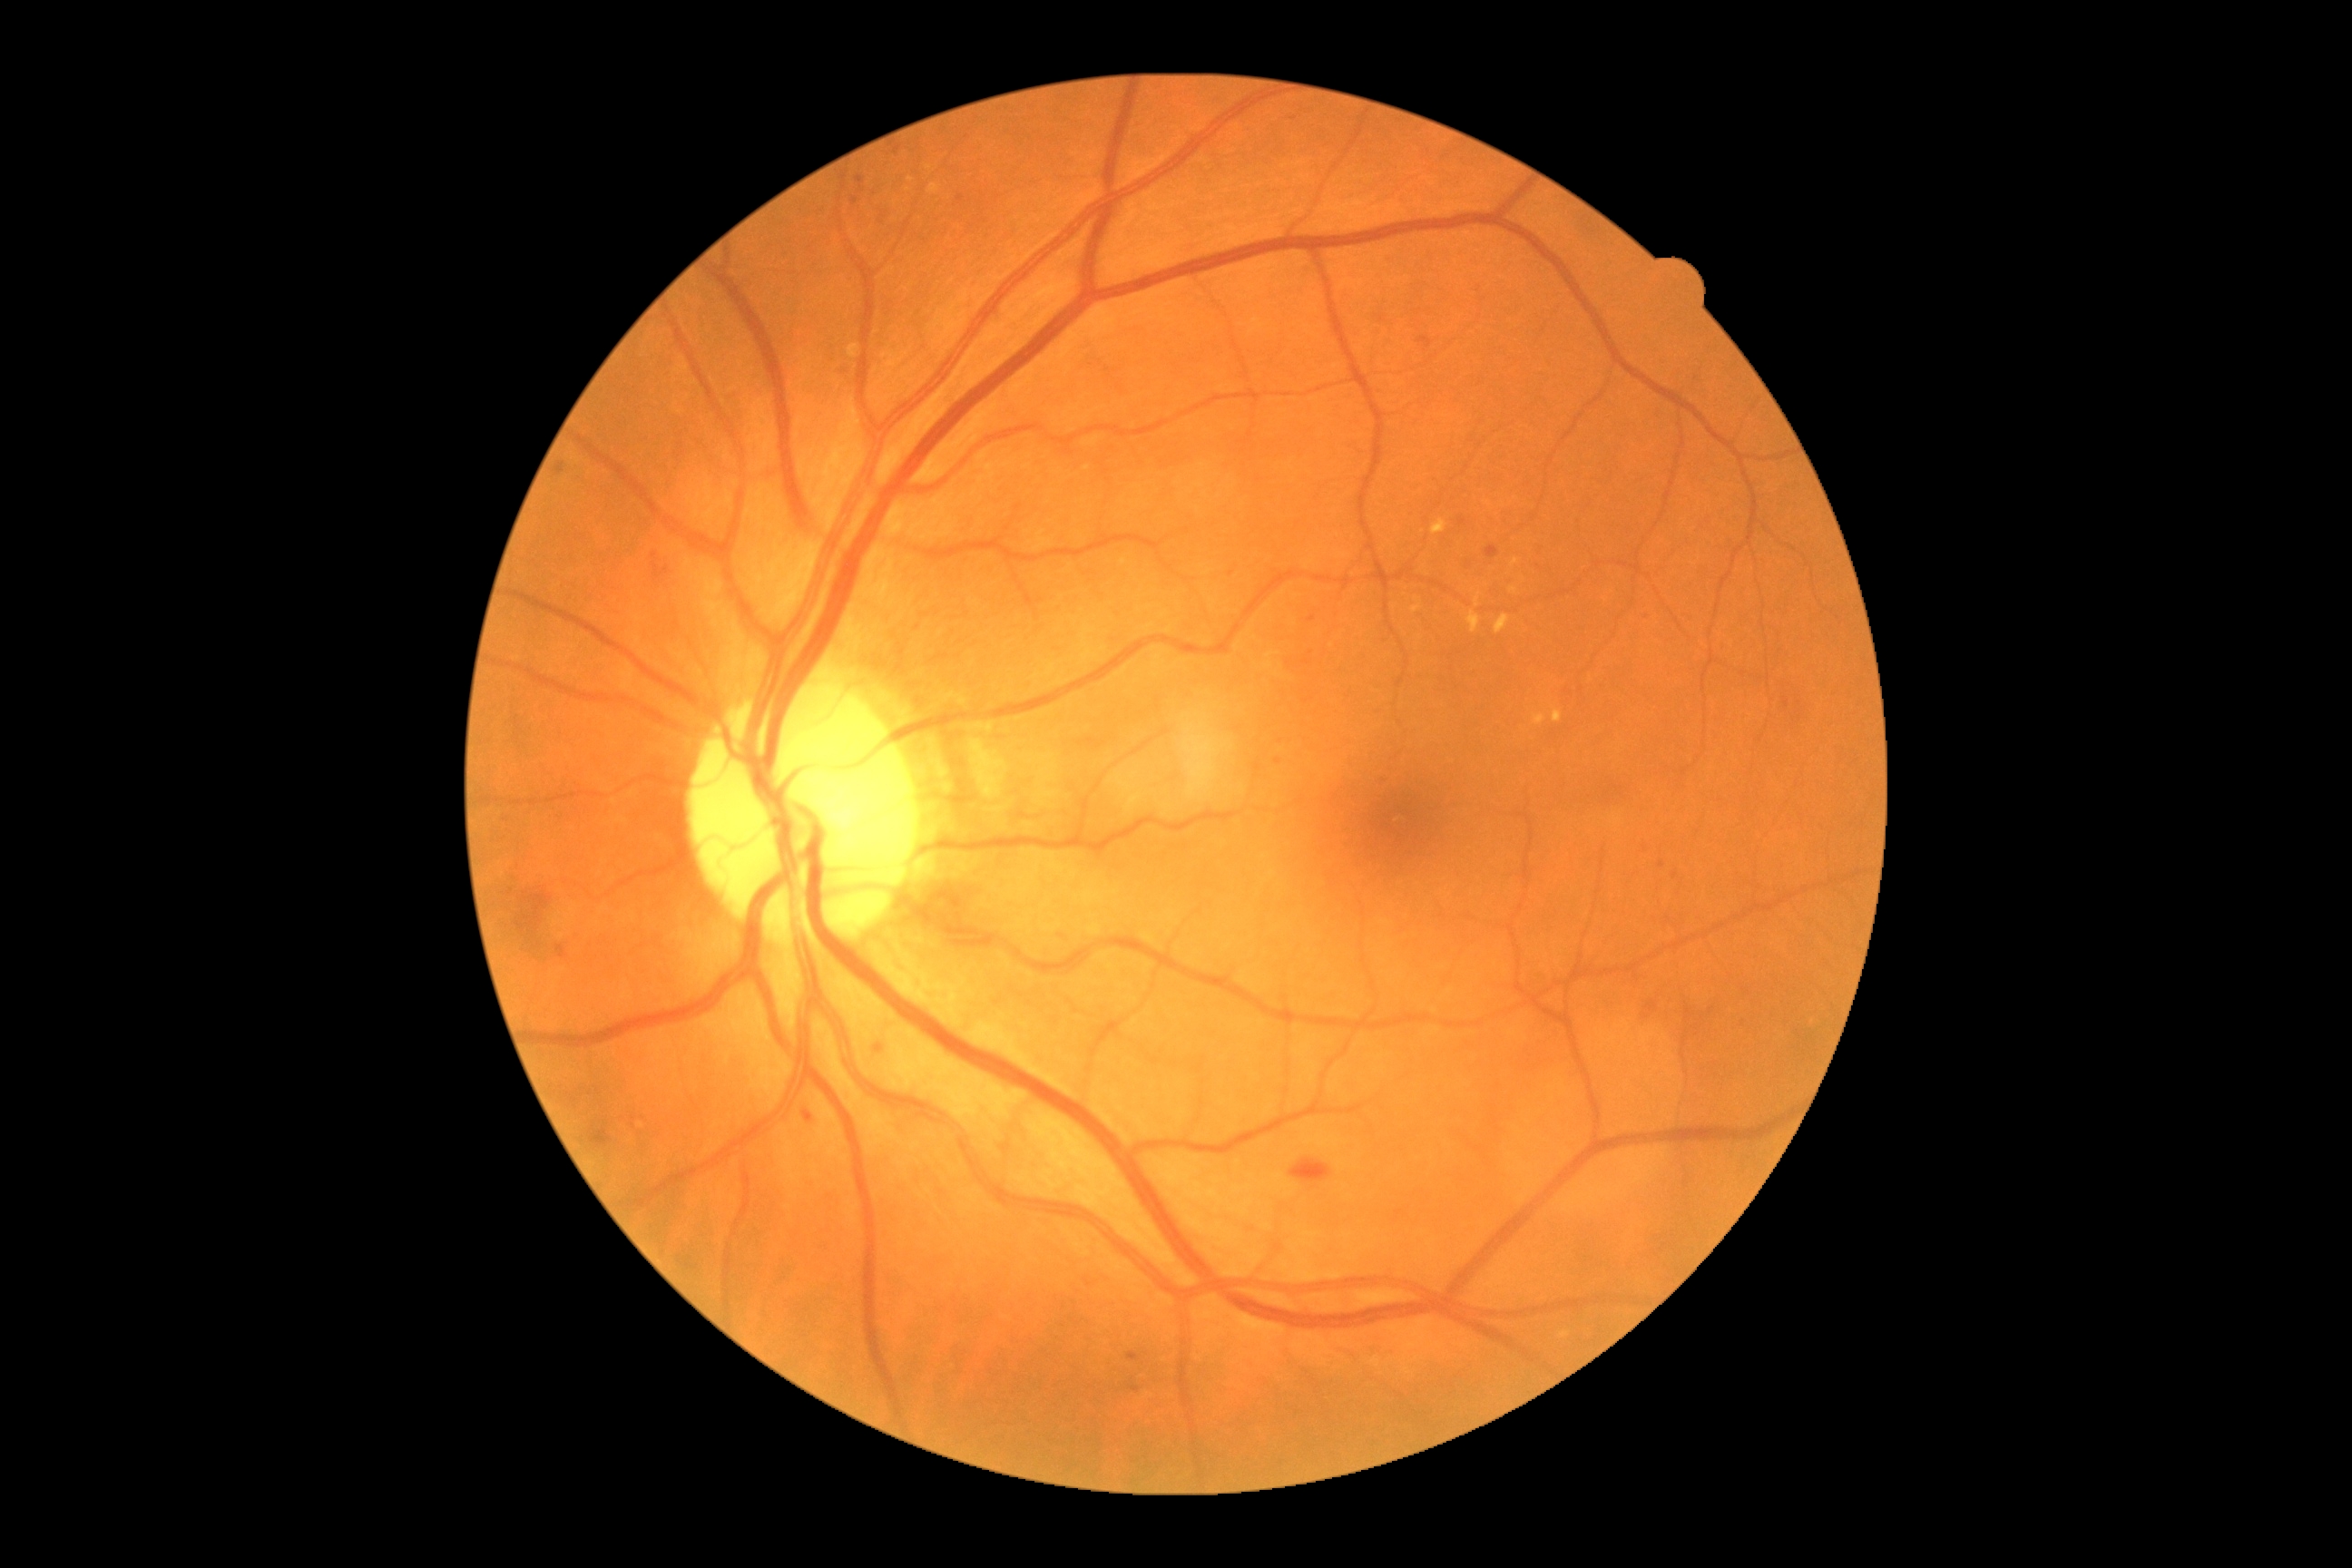
DR severity is grade 2 — more than just microaneurysms but less than severe NPDR
Representative lesions:
MAs (subset): bbox=(803, 1112, 814, 1124); bbox=(856, 177, 865, 184); bbox=(1130, 1387, 1141, 1393); bbox=(876, 1046, 883, 1054); bbox=(1647, 1003, 1658, 1012); bbox=(1128, 1353, 1141, 1362); bbox=(1485, 547, 1500, 560)
MAs (small, approximate centers) near (1232; 573); (1675; 876); (1662; 866); (1278; 762)
EXs (subset): bbox=(928, 184, 939, 195); bbox=(1467, 612, 1482, 634); bbox=(1494, 614, 1511, 634); bbox=(1431, 520, 1447, 536); bbox=(848, 344, 859, 358); bbox=(1534, 714, 1547, 727); bbox=(1411, 605, 1422, 612); bbox=(1553, 707, 1563, 723); bbox=(1476, 596, 1480, 607)
EXs (small, approximate centers) near (911; 179); (1514; 563); (1514; 590); (1416; 600)
SEs: not present
HEs: bbox=(591, 1128, 612, 1148); bbox=(556, 946, 569, 959); bbox=(652, 564, 671, 582); bbox=(522, 892, 553, 928); bbox=(1291, 1159, 1333, 1184)